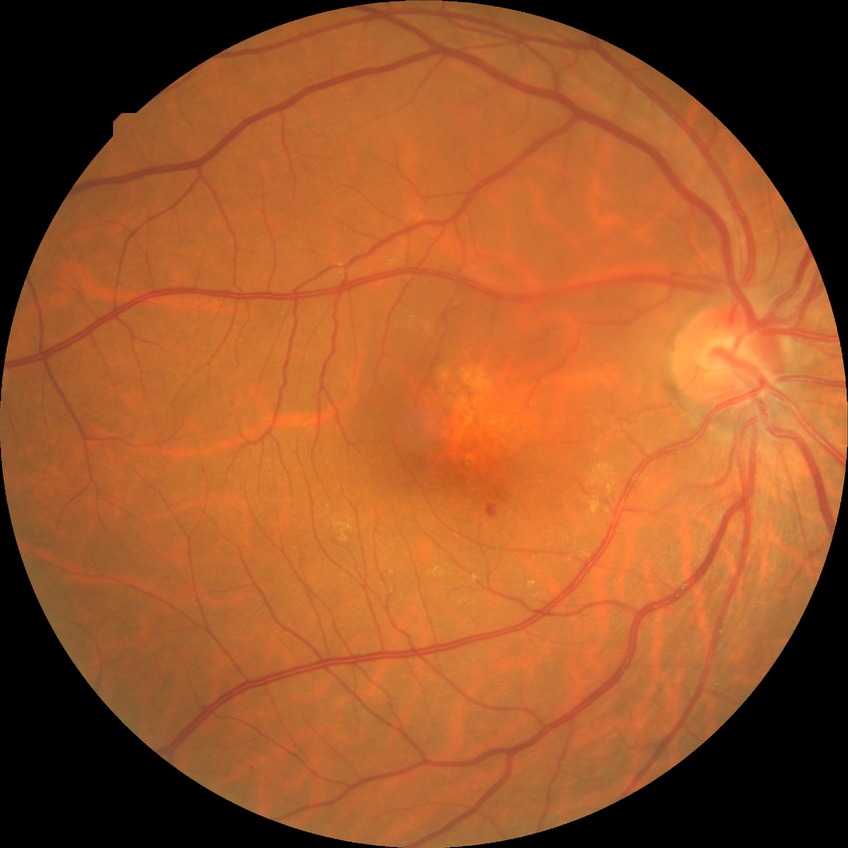 Retinopathy stage is simple diabetic retinopathy.